1924 by 1556 pixels, ultra-widefield (UWF) fundus image.
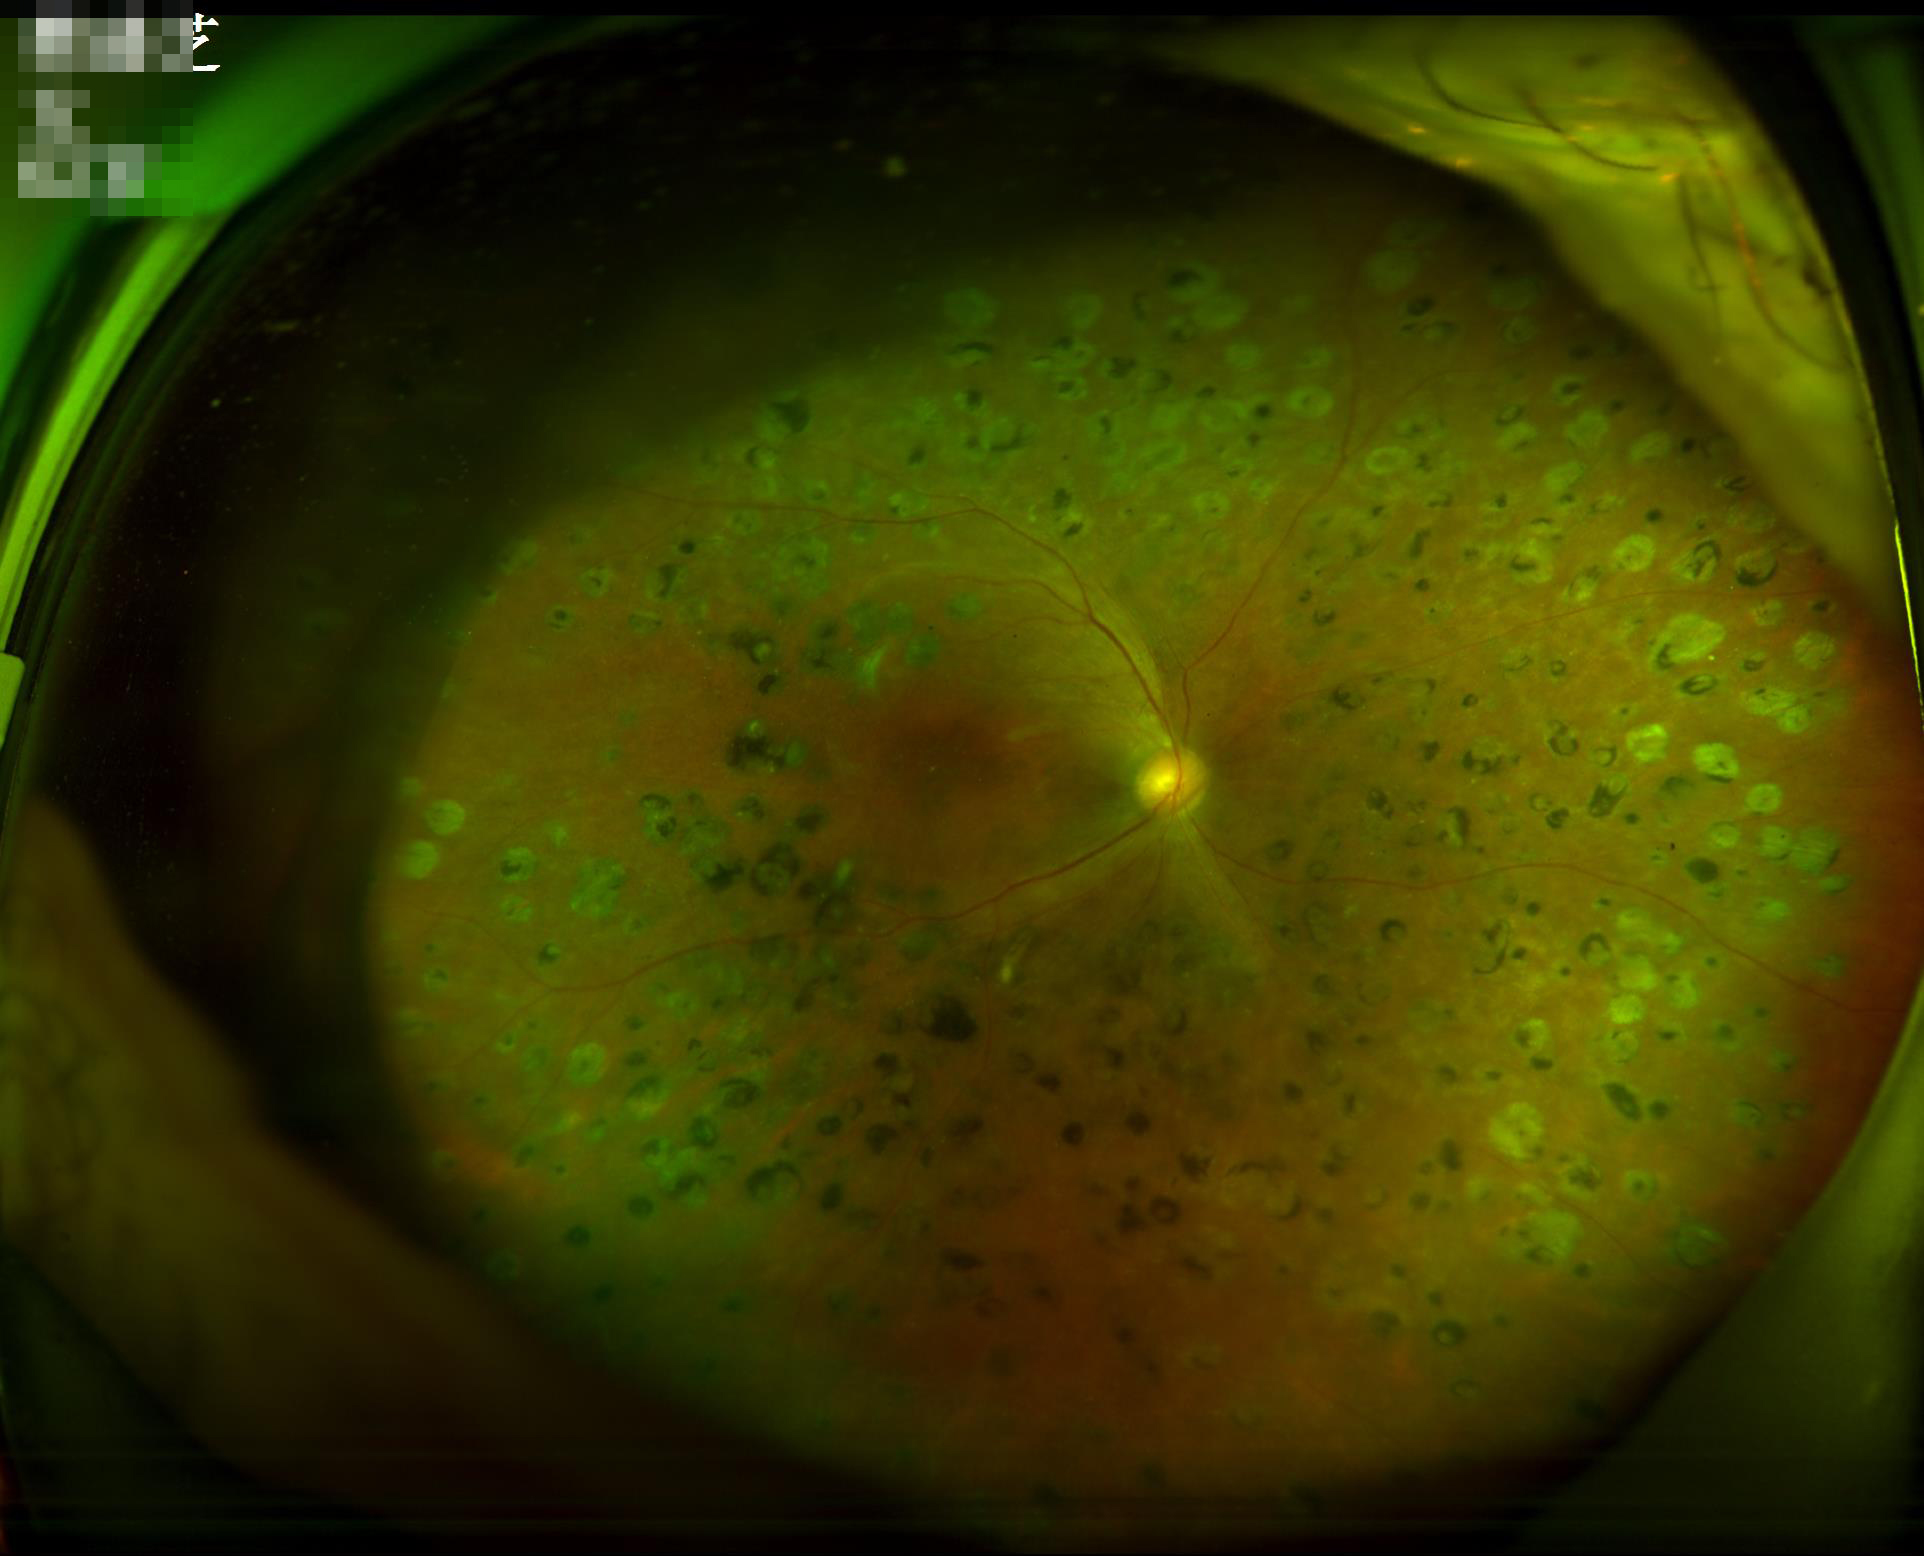 Illumination and color are suboptimal. Image quality is adequate for diagnostic use.